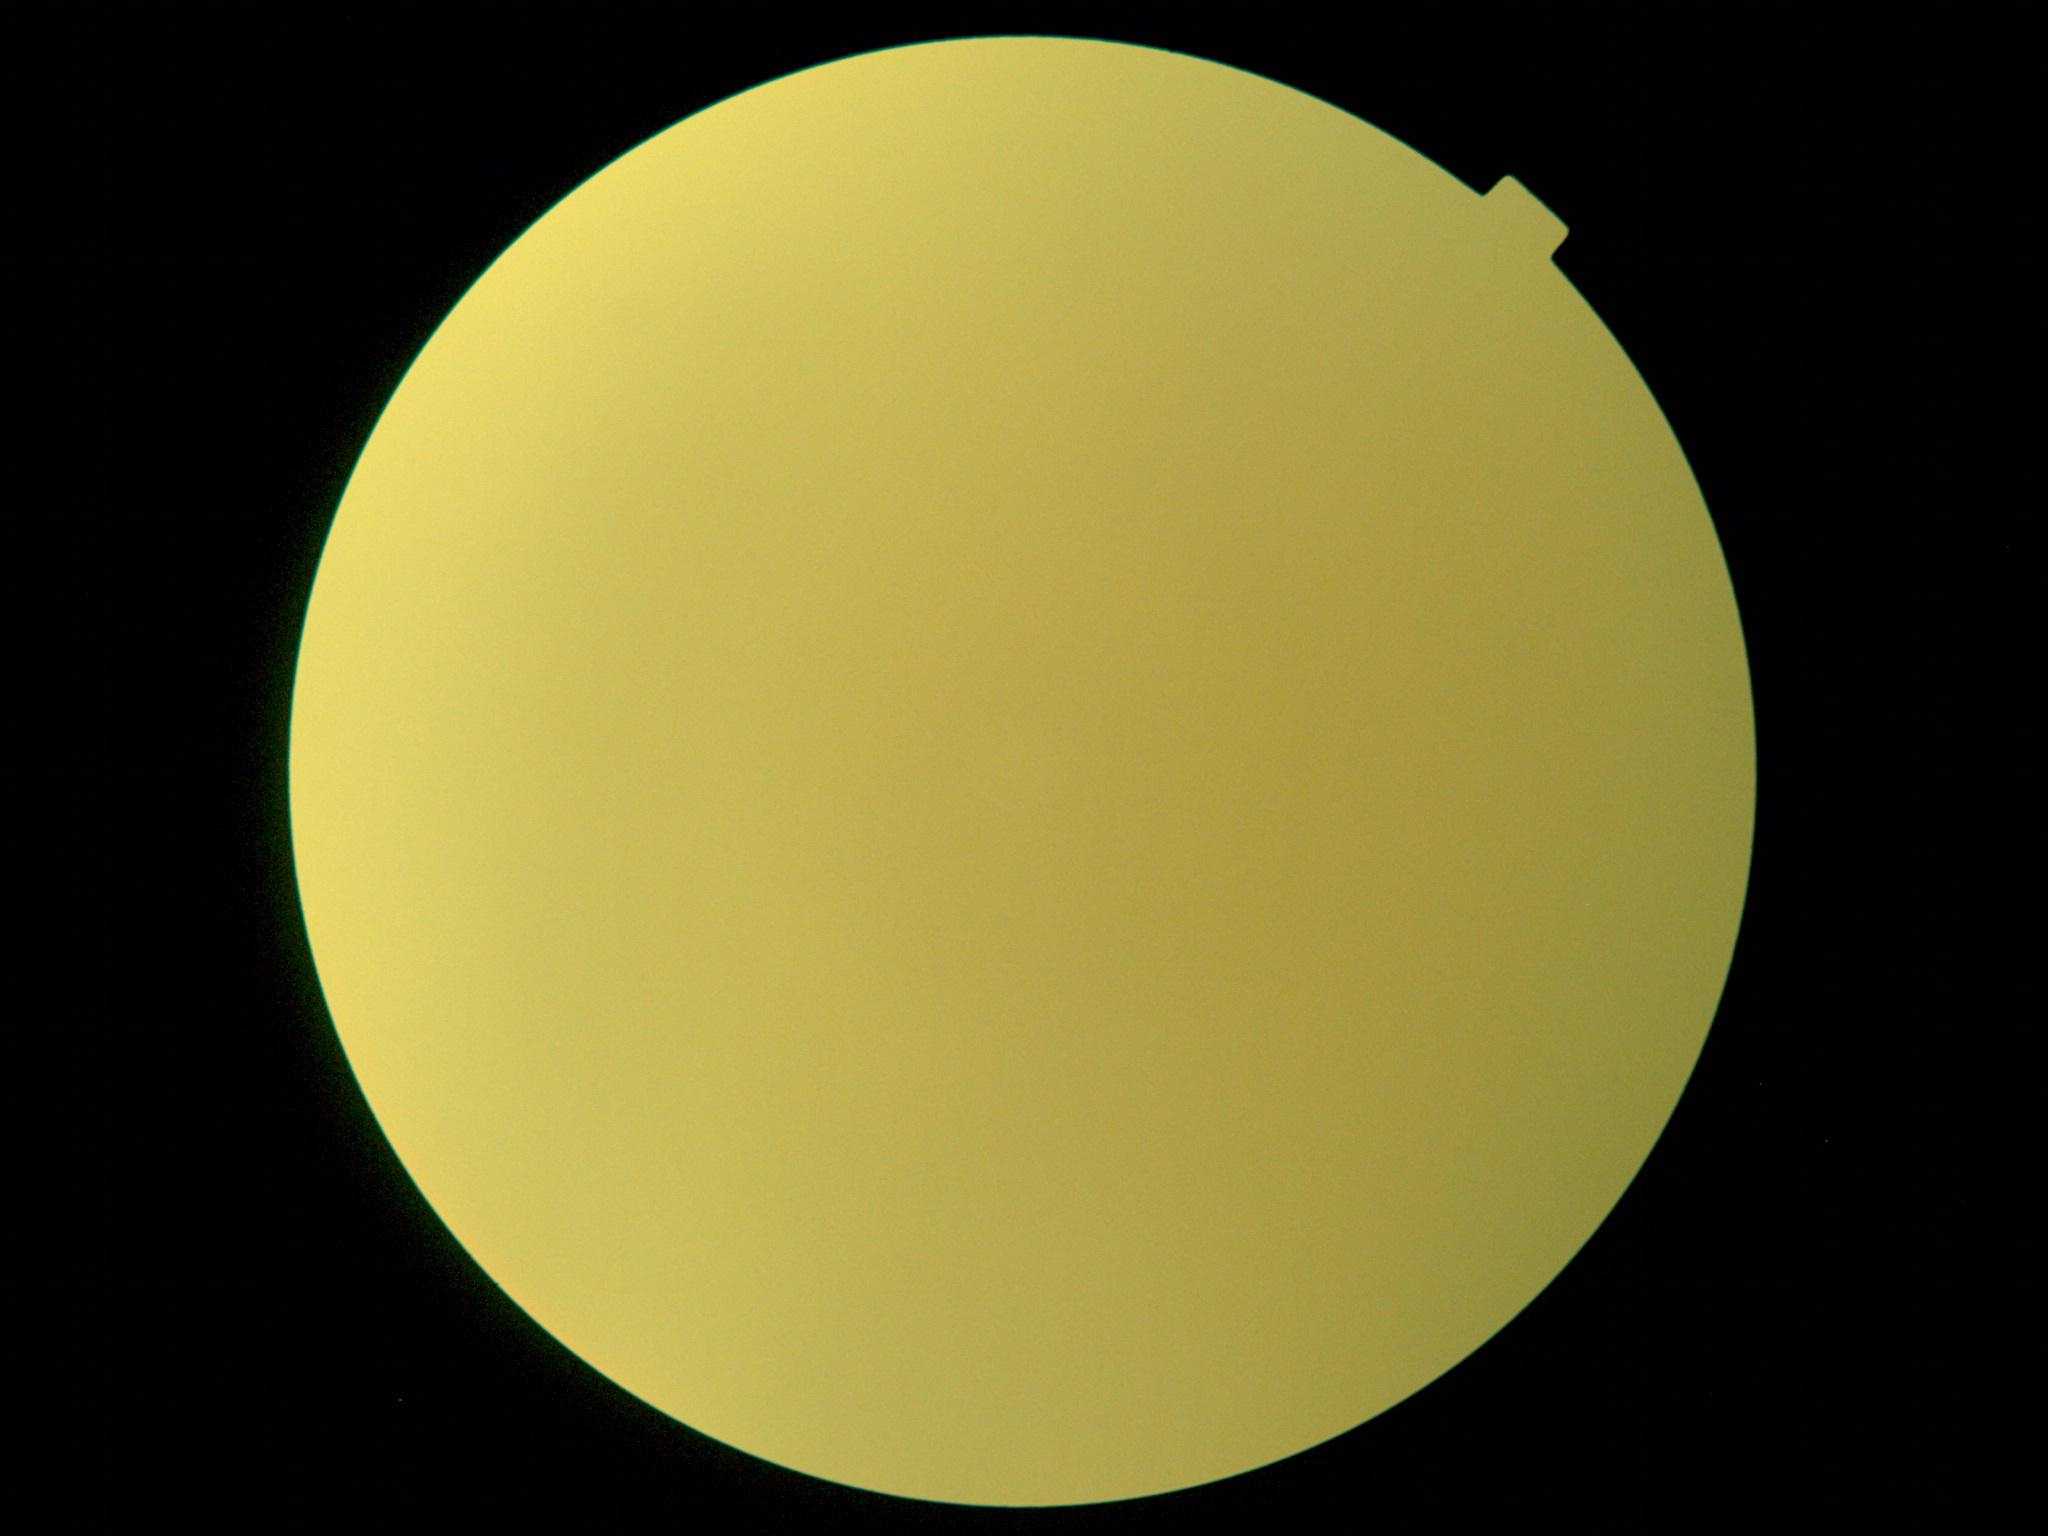

diabetic retinopathy@ungradable due to poor image quality; image quality@insufficient for DR assessment.